45° FOV, 2352x1568, color fundus photograph
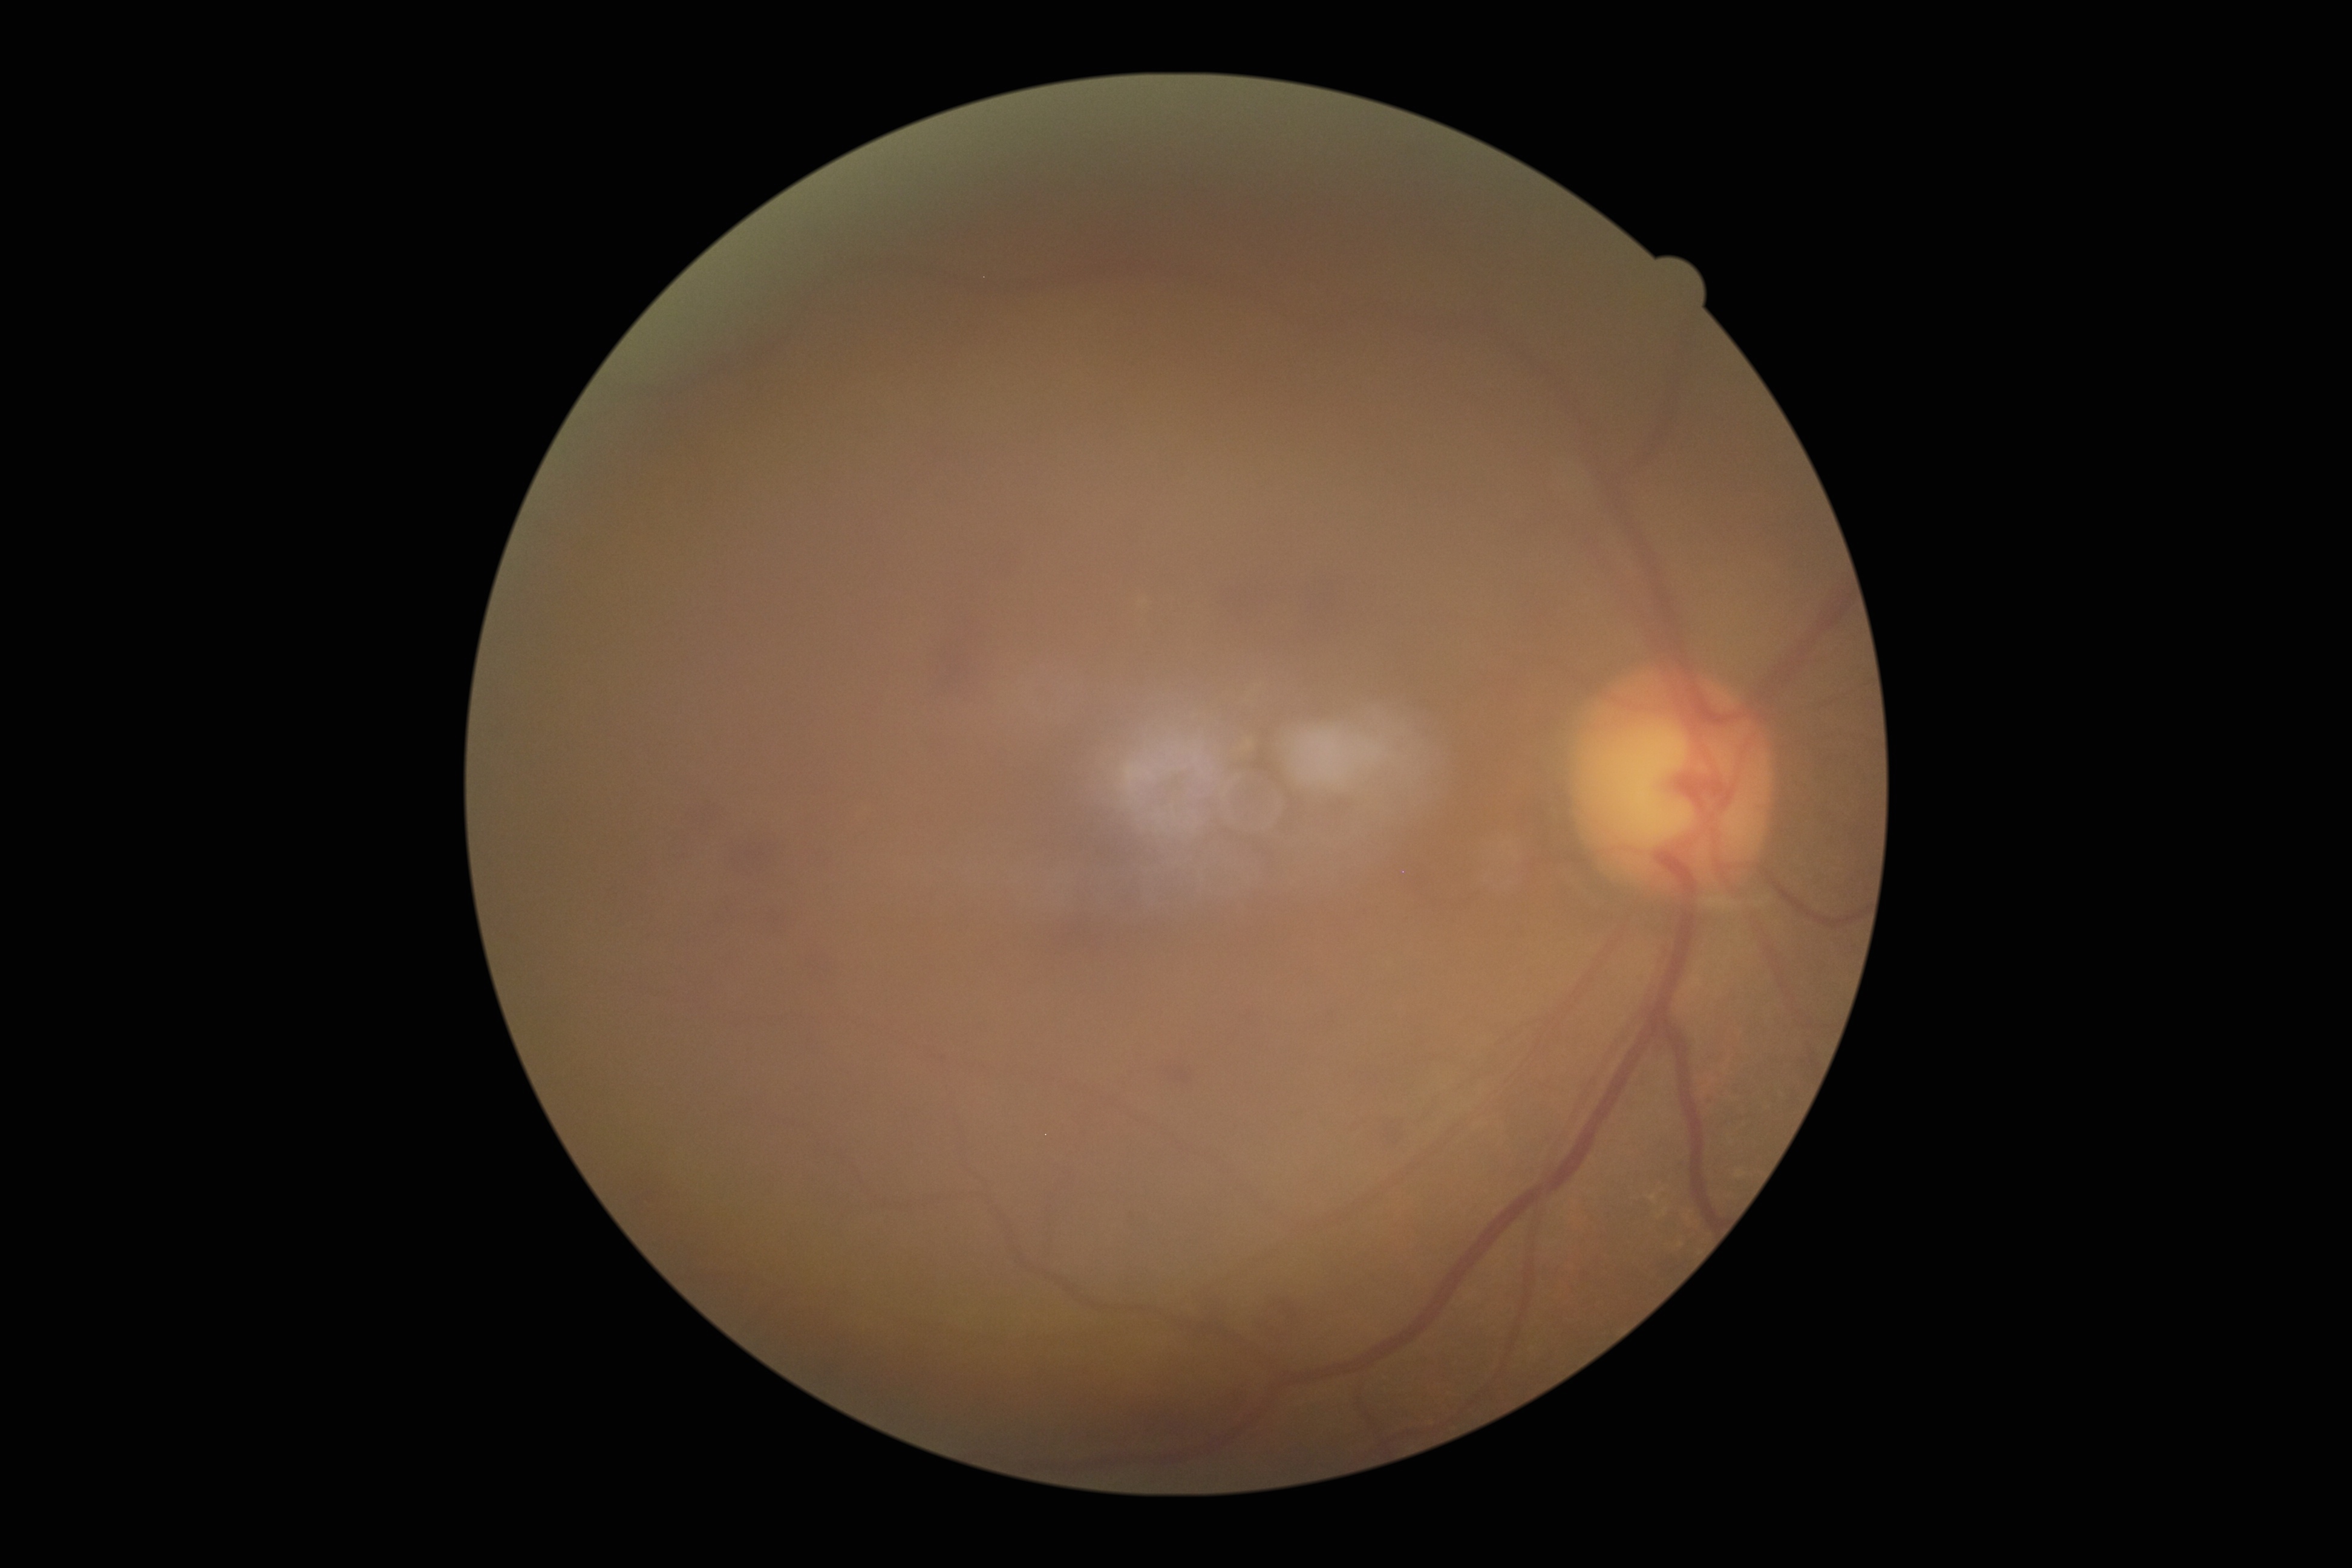
Diabetic retinopathy: 2/4.